Graded on the modified Davis scale:
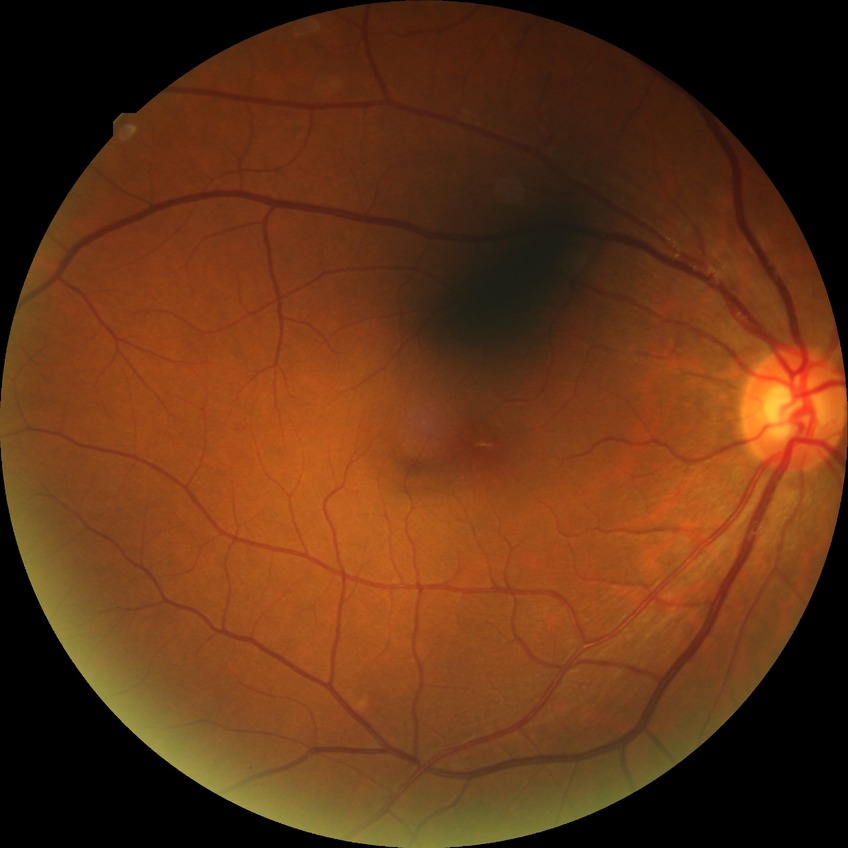

Retinopathy stage: no diabetic retinopathy.